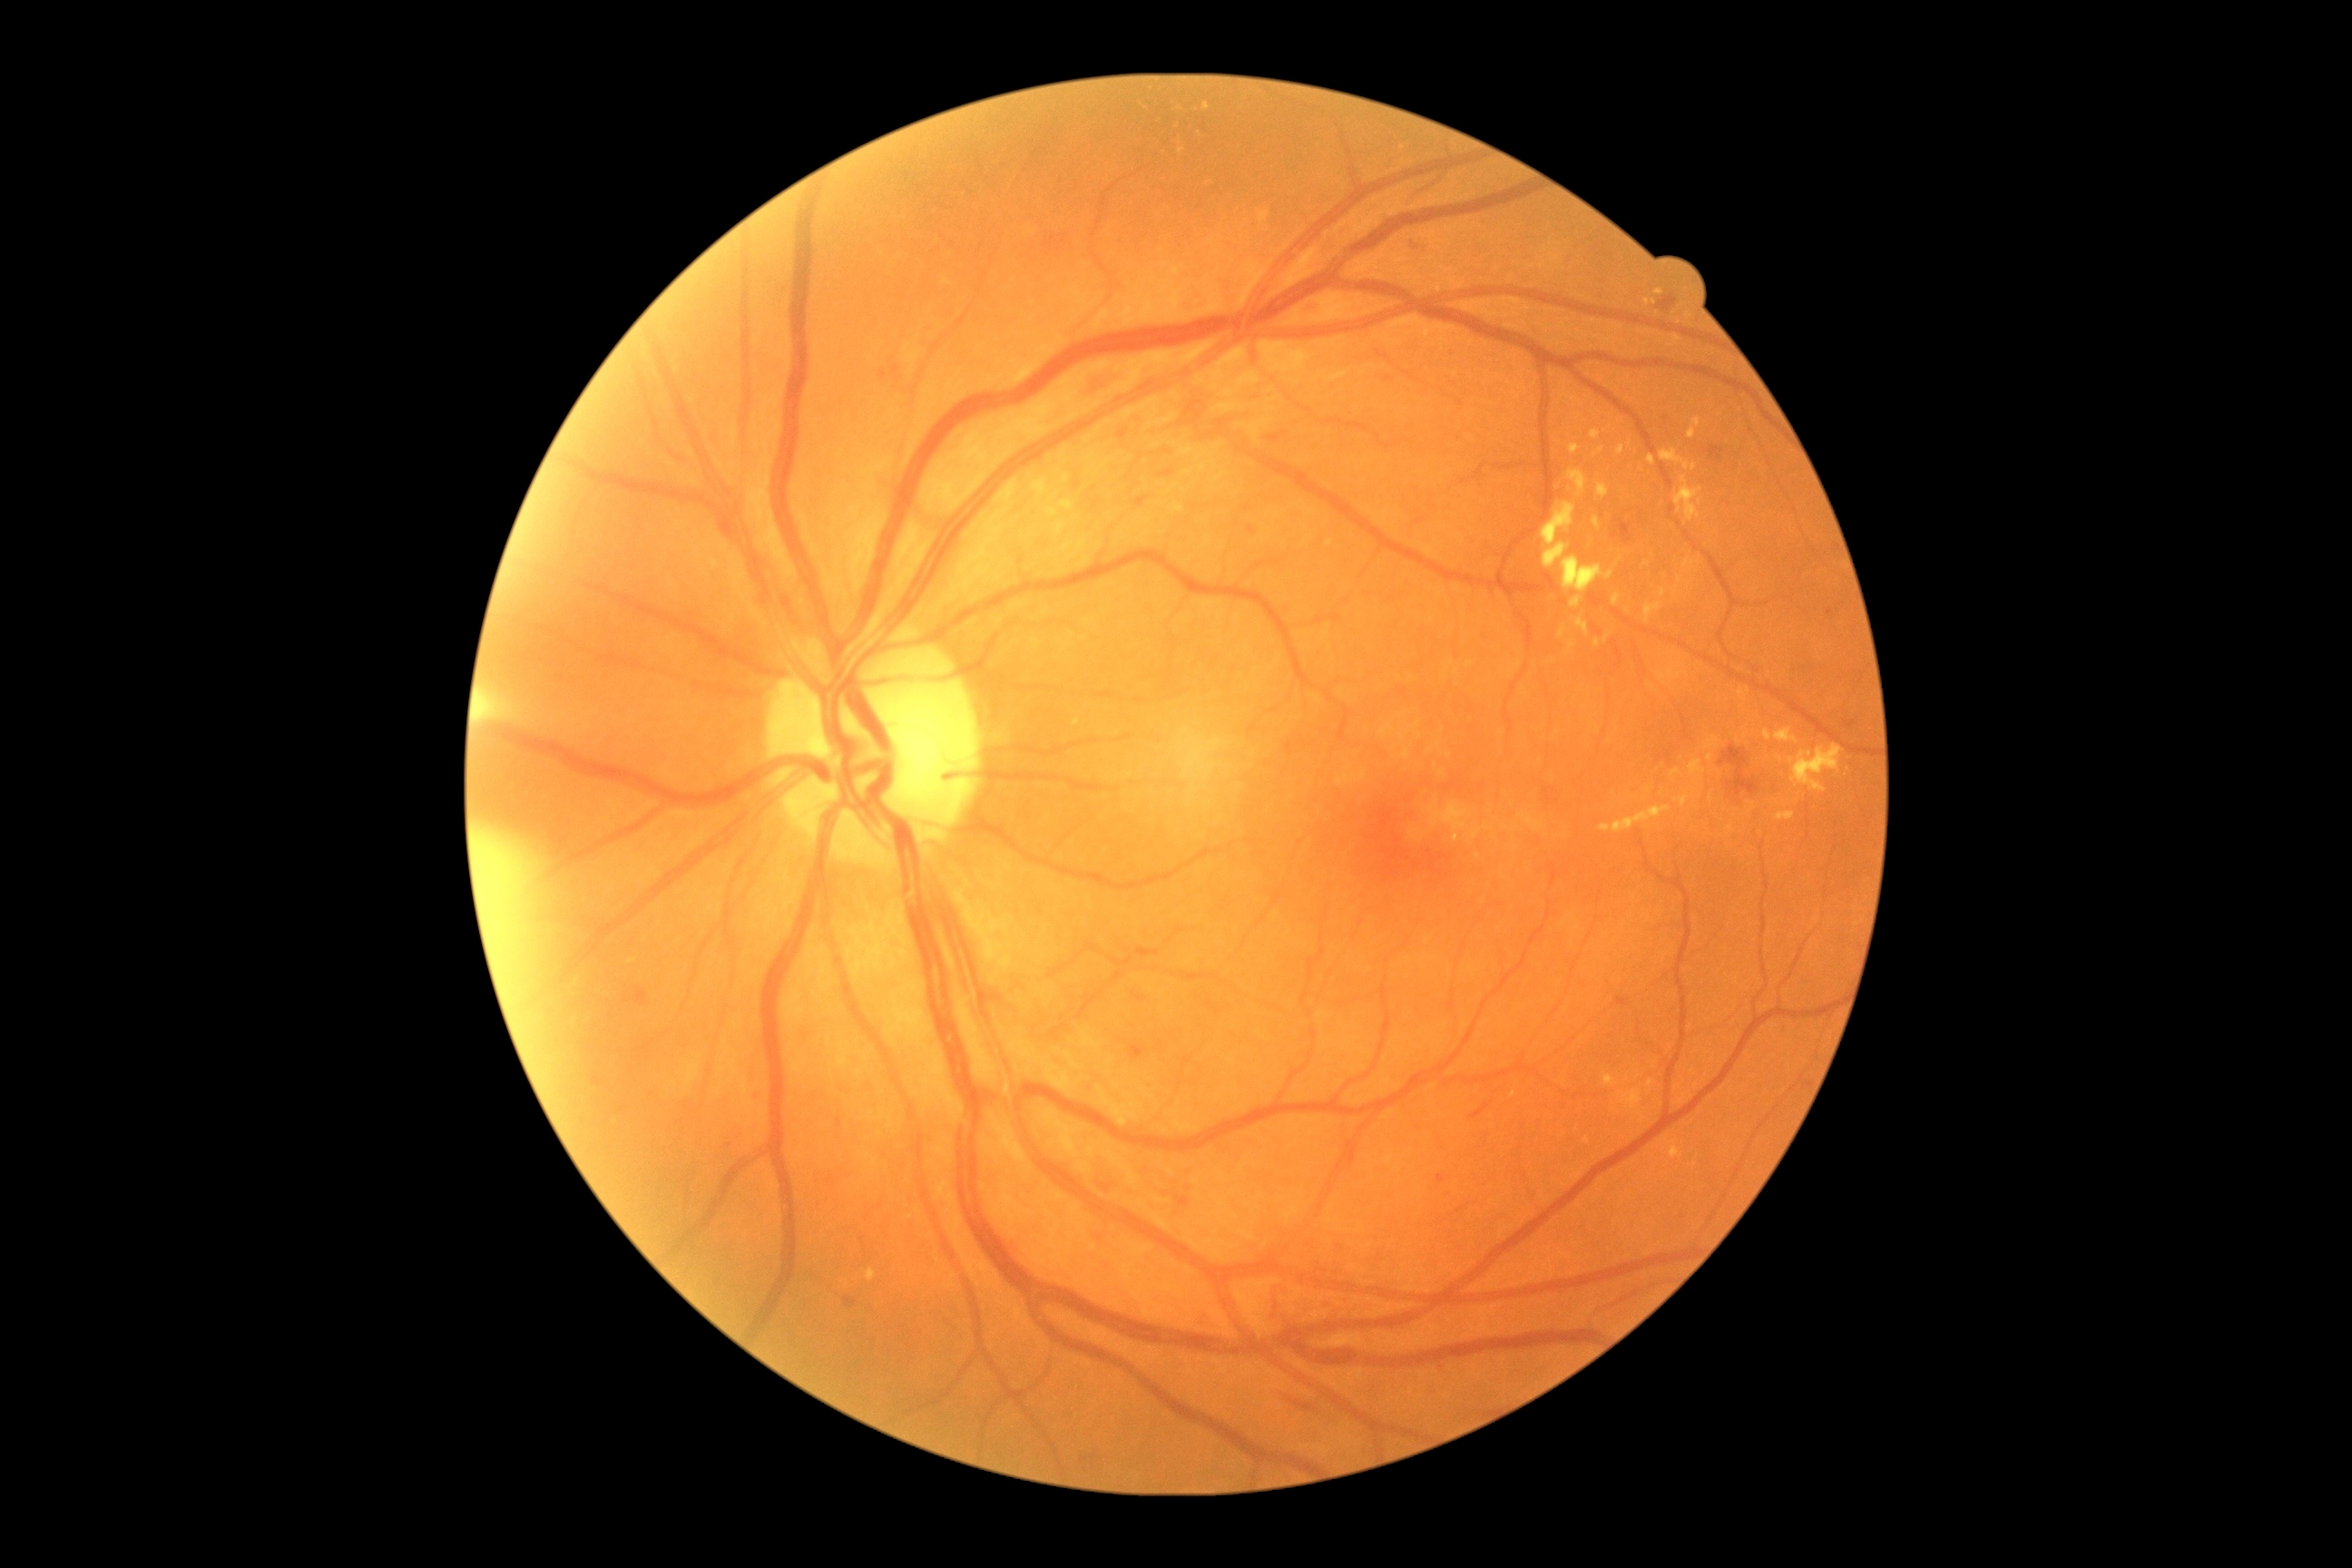

Diabetic retinopathy: moderate NPDR (grade 2); non-proliferative diabetic retinopathy
Representative lesions:
hard exudates (continued): (1612, 594, 1620, 605), (1707, 754, 1714, 763), (1573, 616, 1589, 638), (1647, 455, 1656, 466), (1046, 500, 1075, 518), (1571, 596, 1583, 609), (1569, 640, 1578, 651), (1592, 516, 1602, 531), (1600, 807, 1672, 834), (1705, 736, 1720, 750), (1594, 640, 1602, 649)
Small hard exudates approximately at point(1680, 579), point(1197, 131), point(1616, 565), point(1781, 759), point(632, 962)